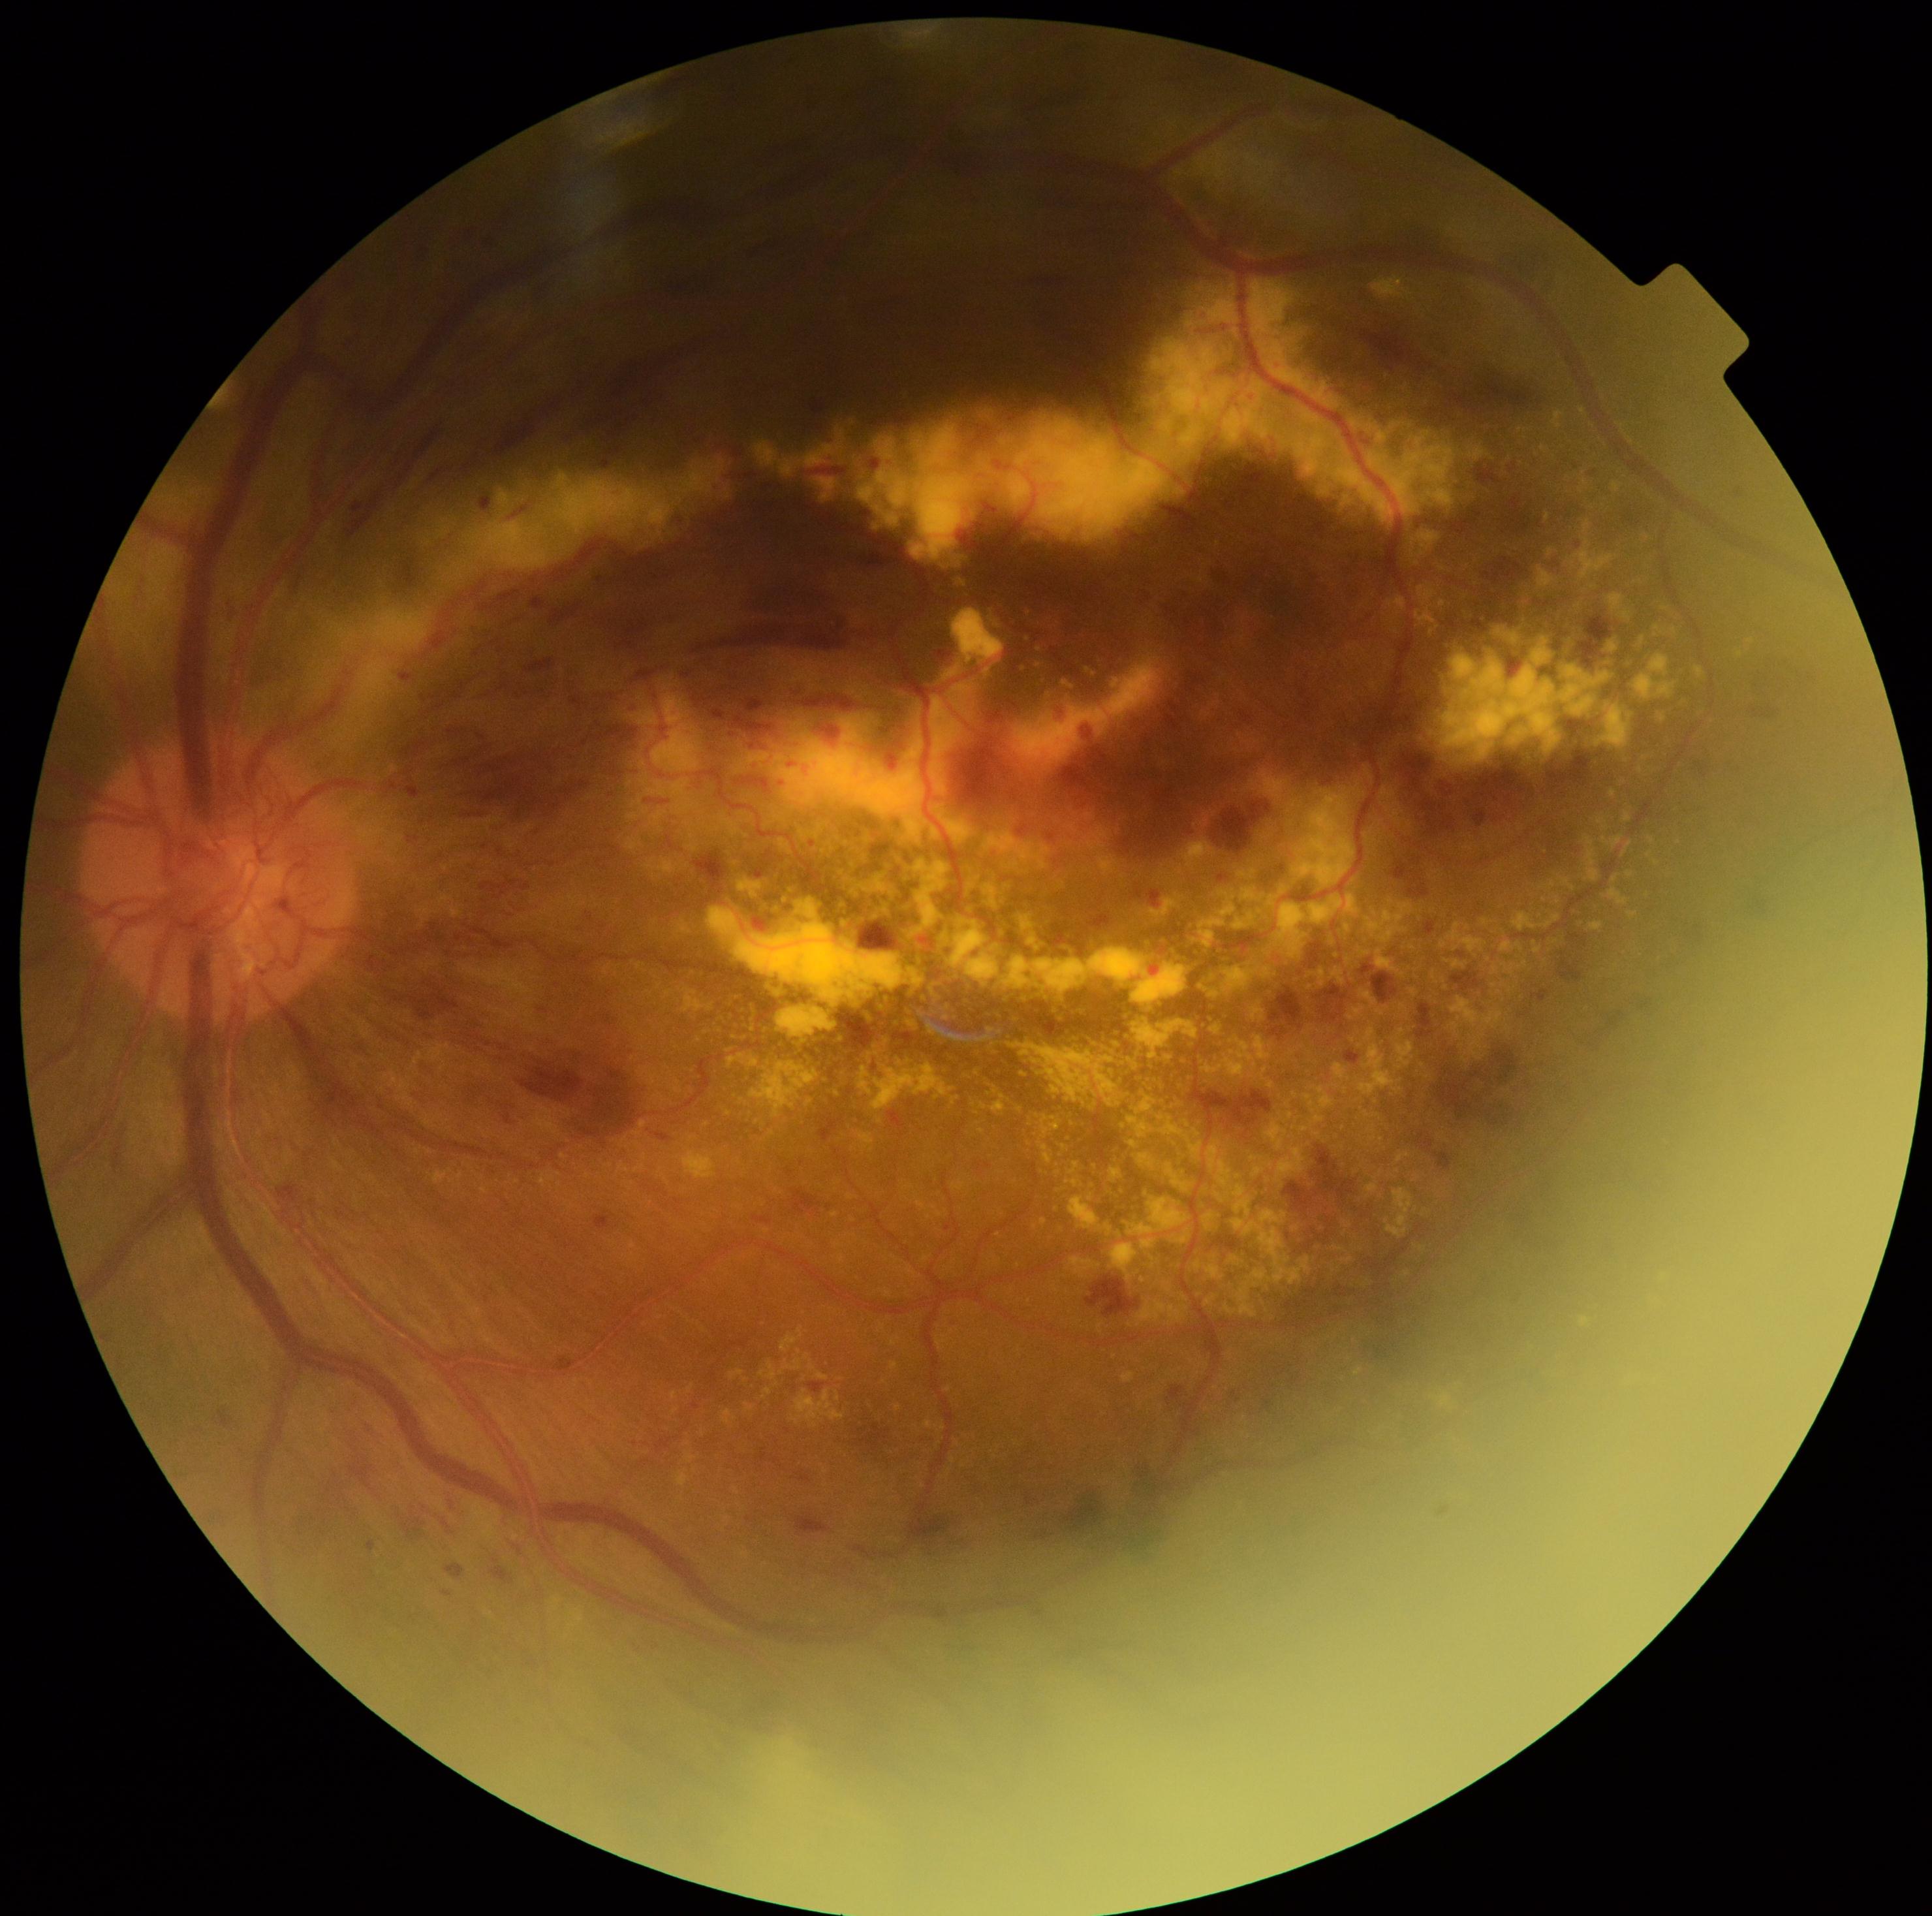
Annotations:
- diabetic retinopathy grade — 4 (PDR)
- DR class — proliferative diabetic retinopathy